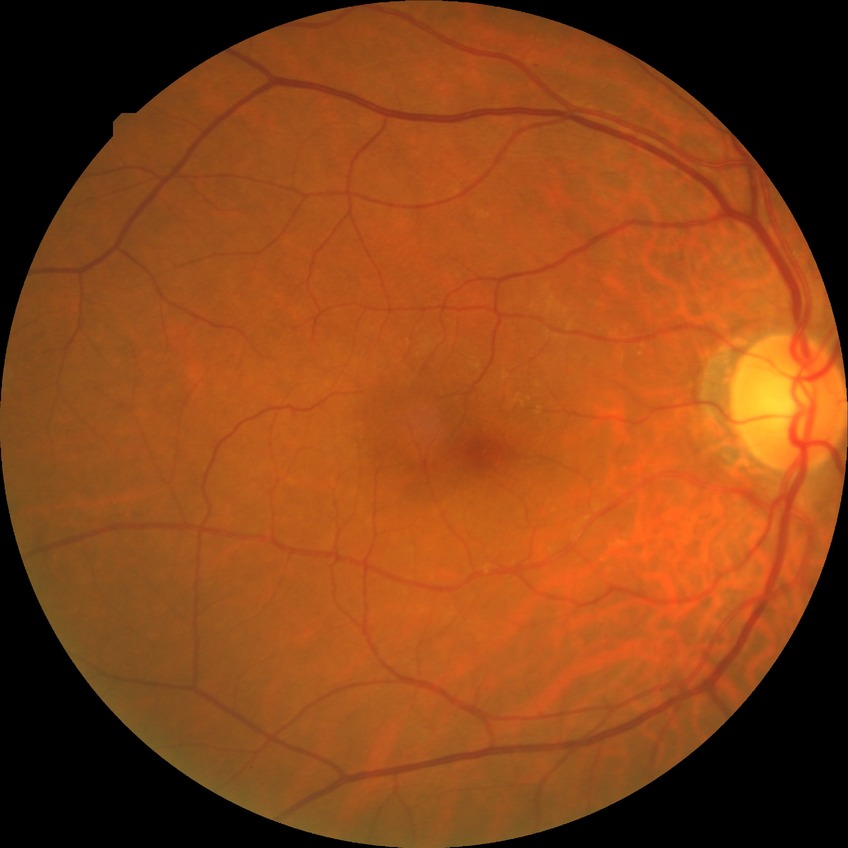

DR: NDR.